Retinal fundus photograph
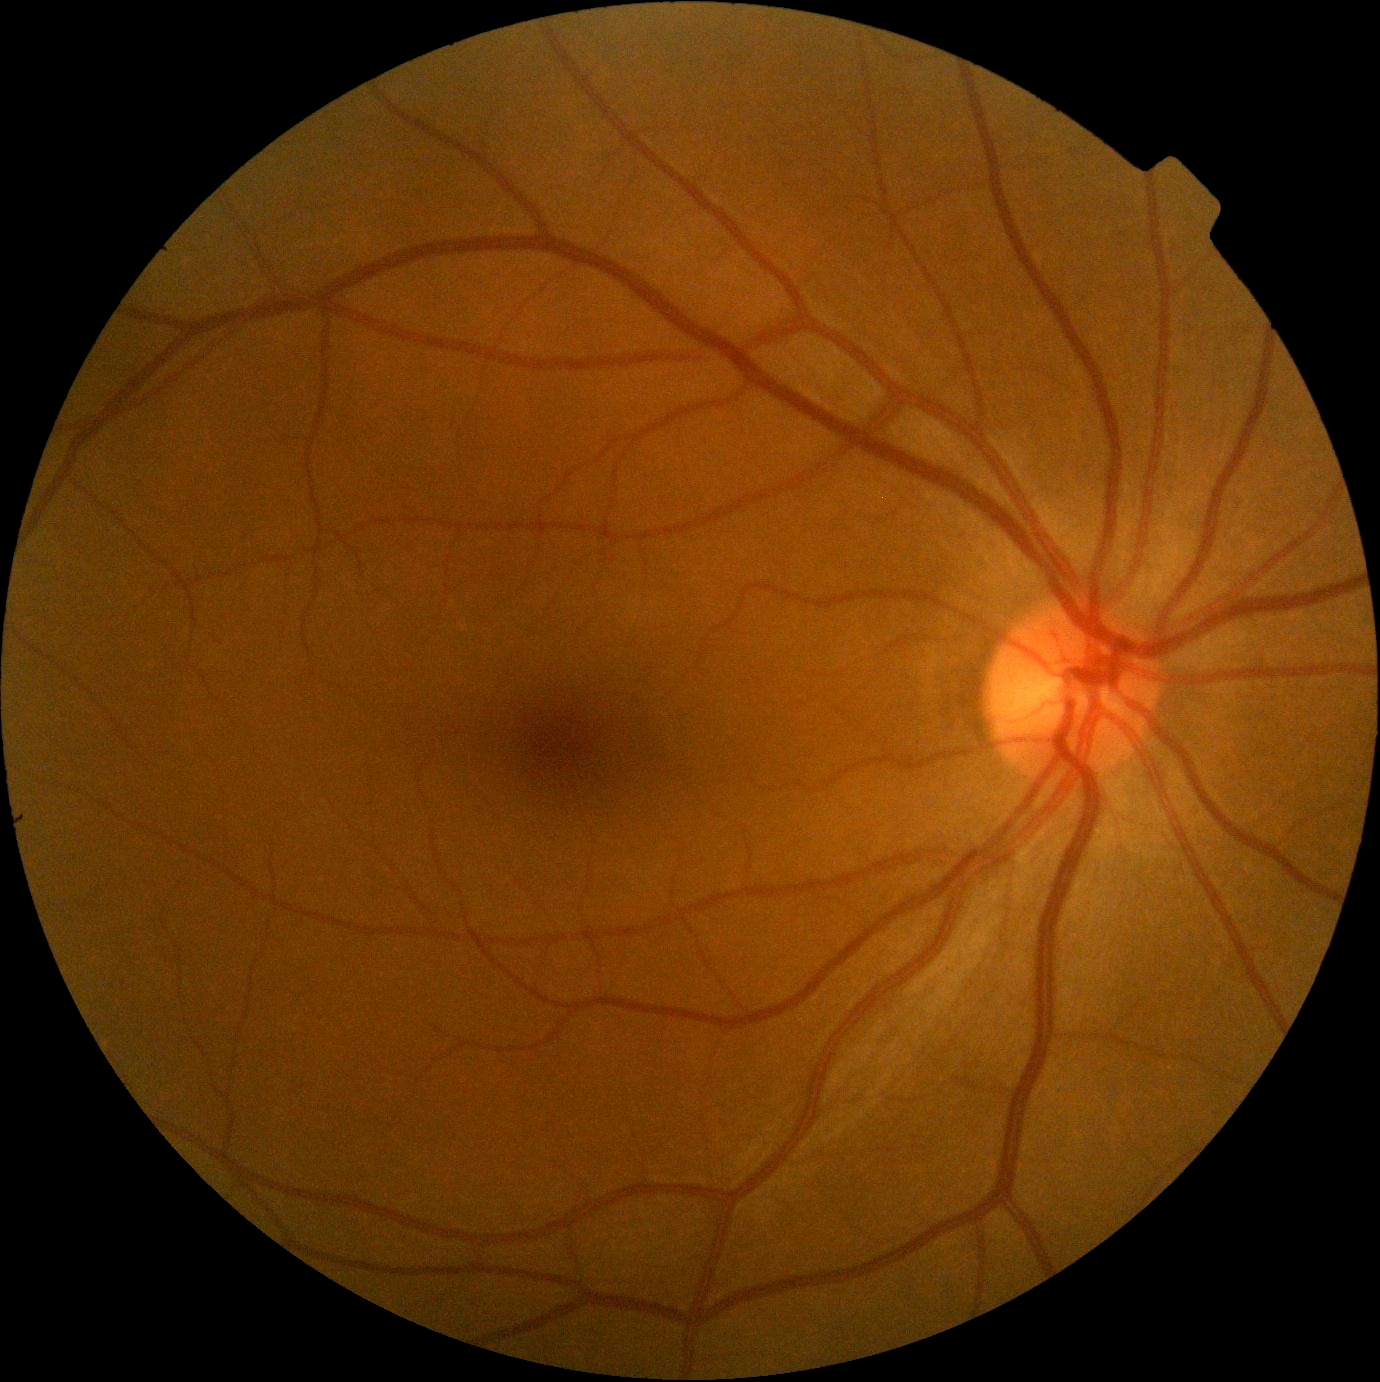

DR stage is 0/4.
No signs of diabetic retinopathy.